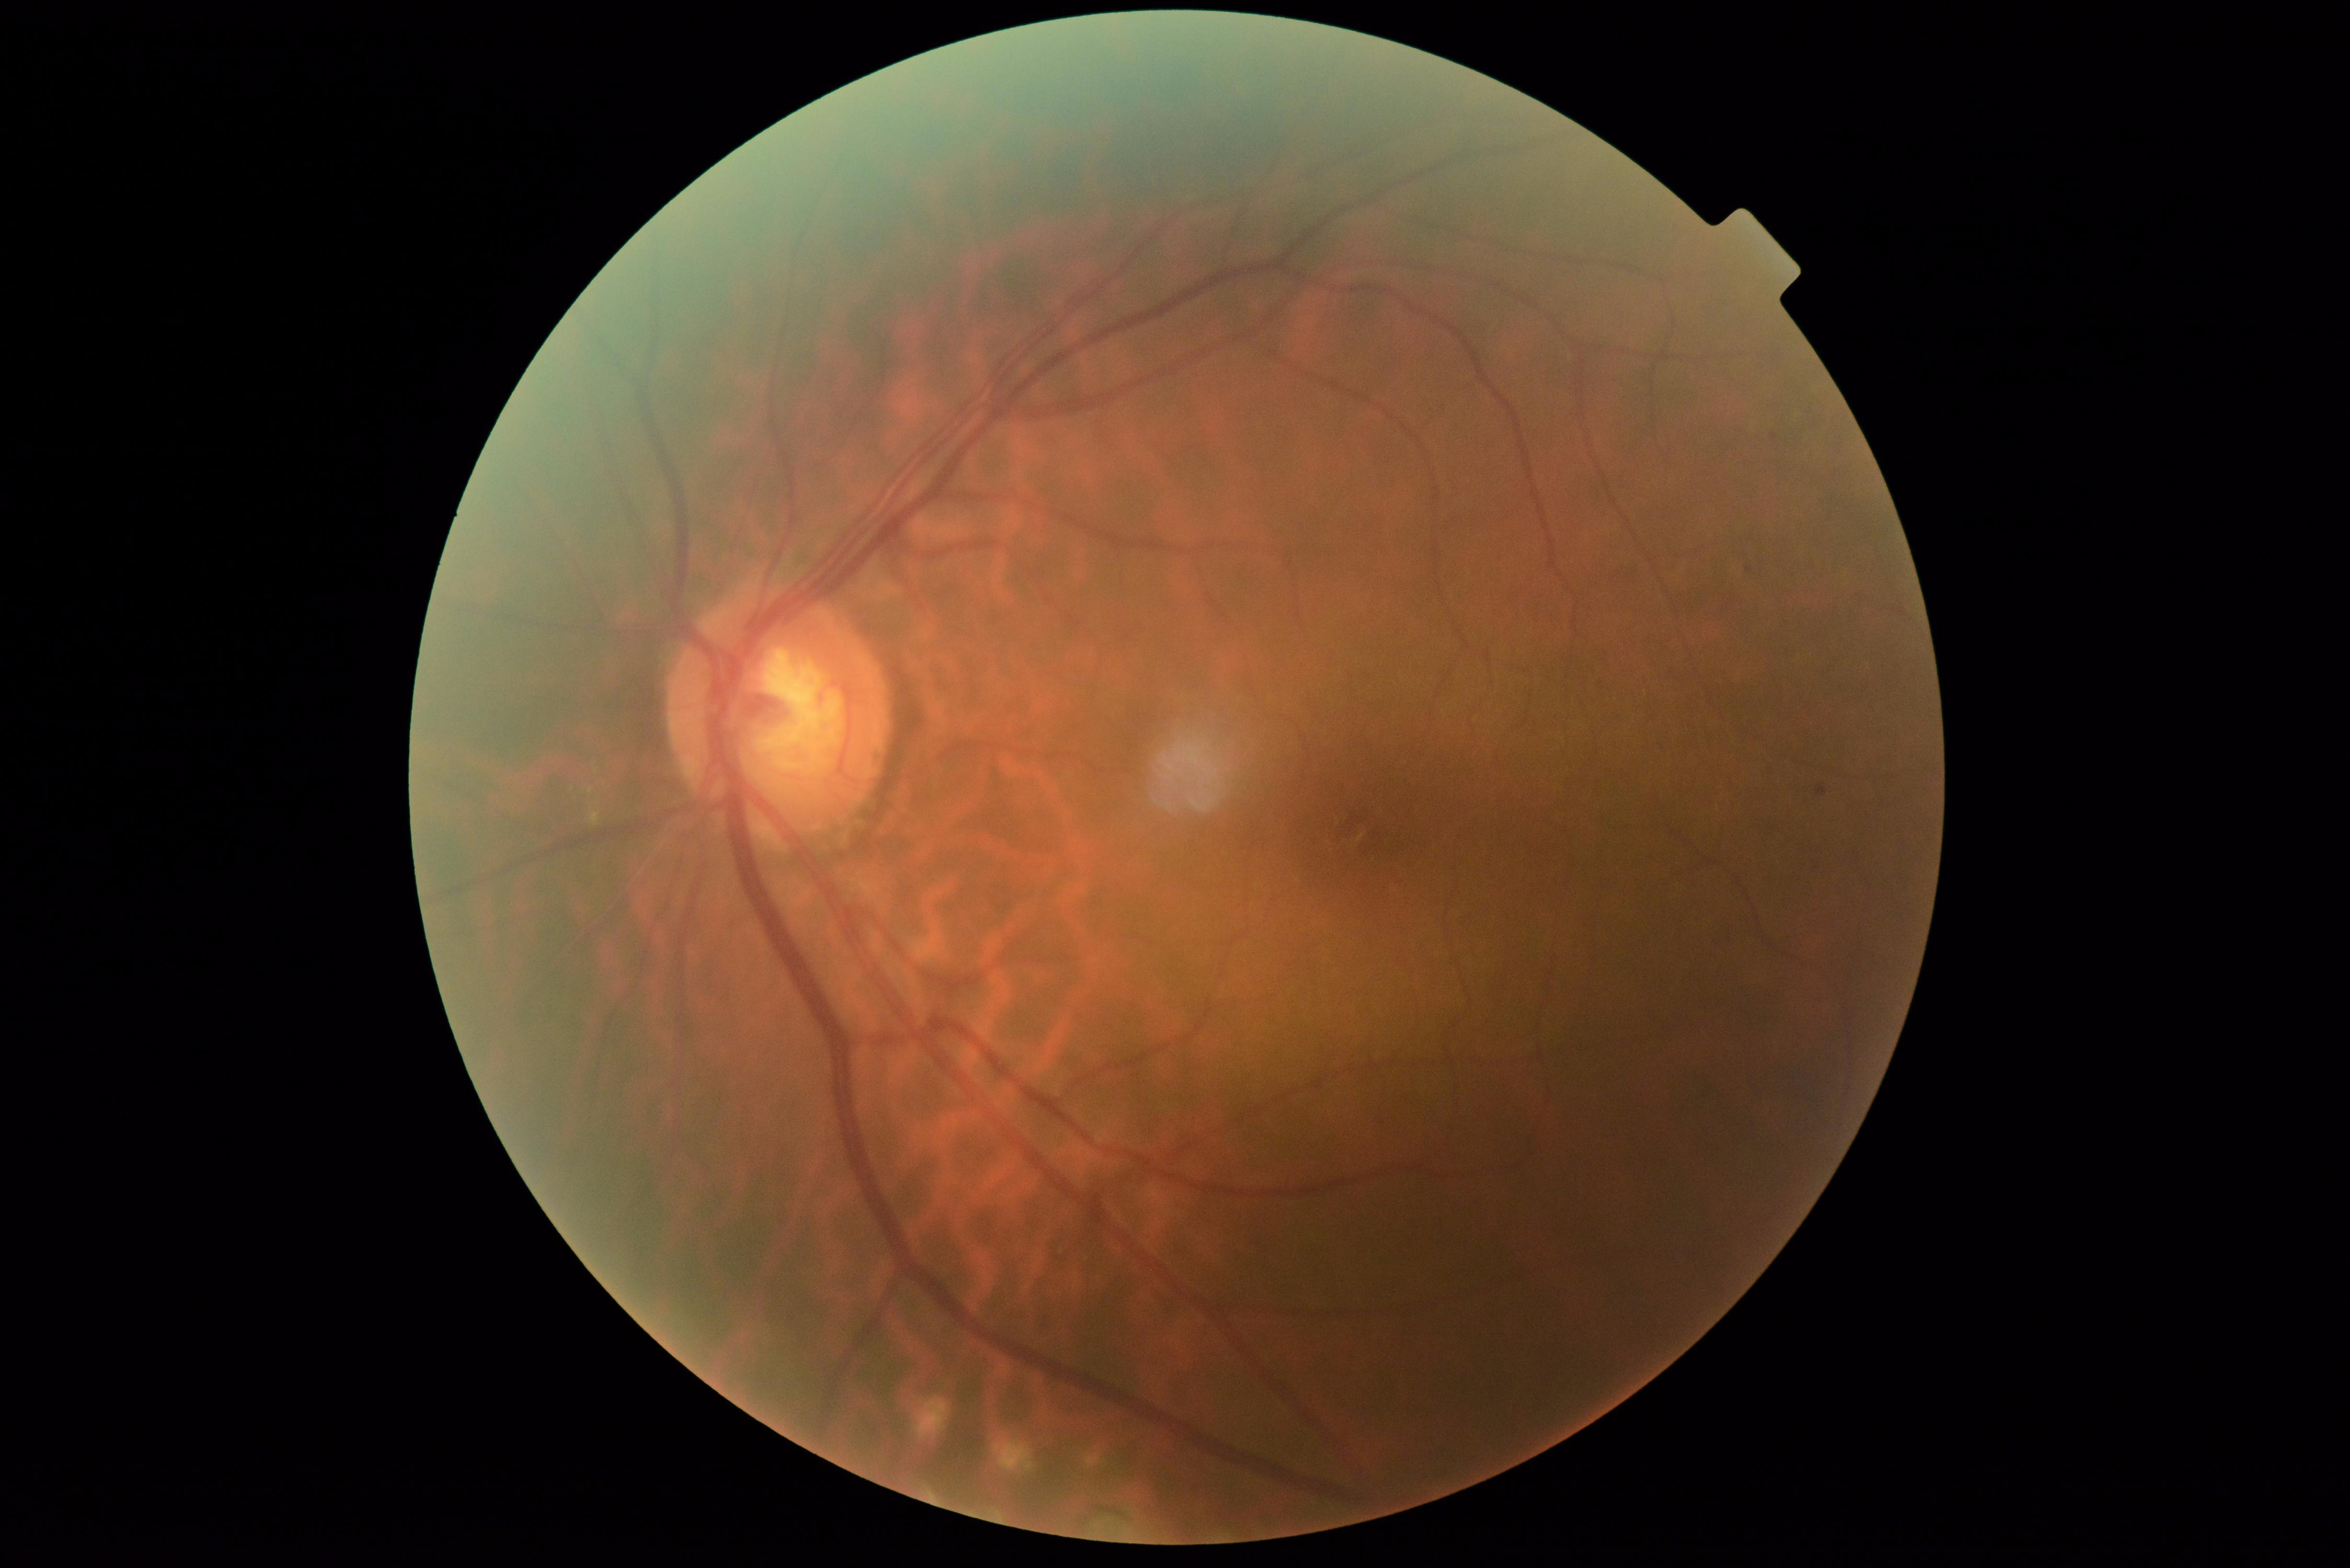

Annotations:
- retinopathy grade — 2 (moderate NPDR)